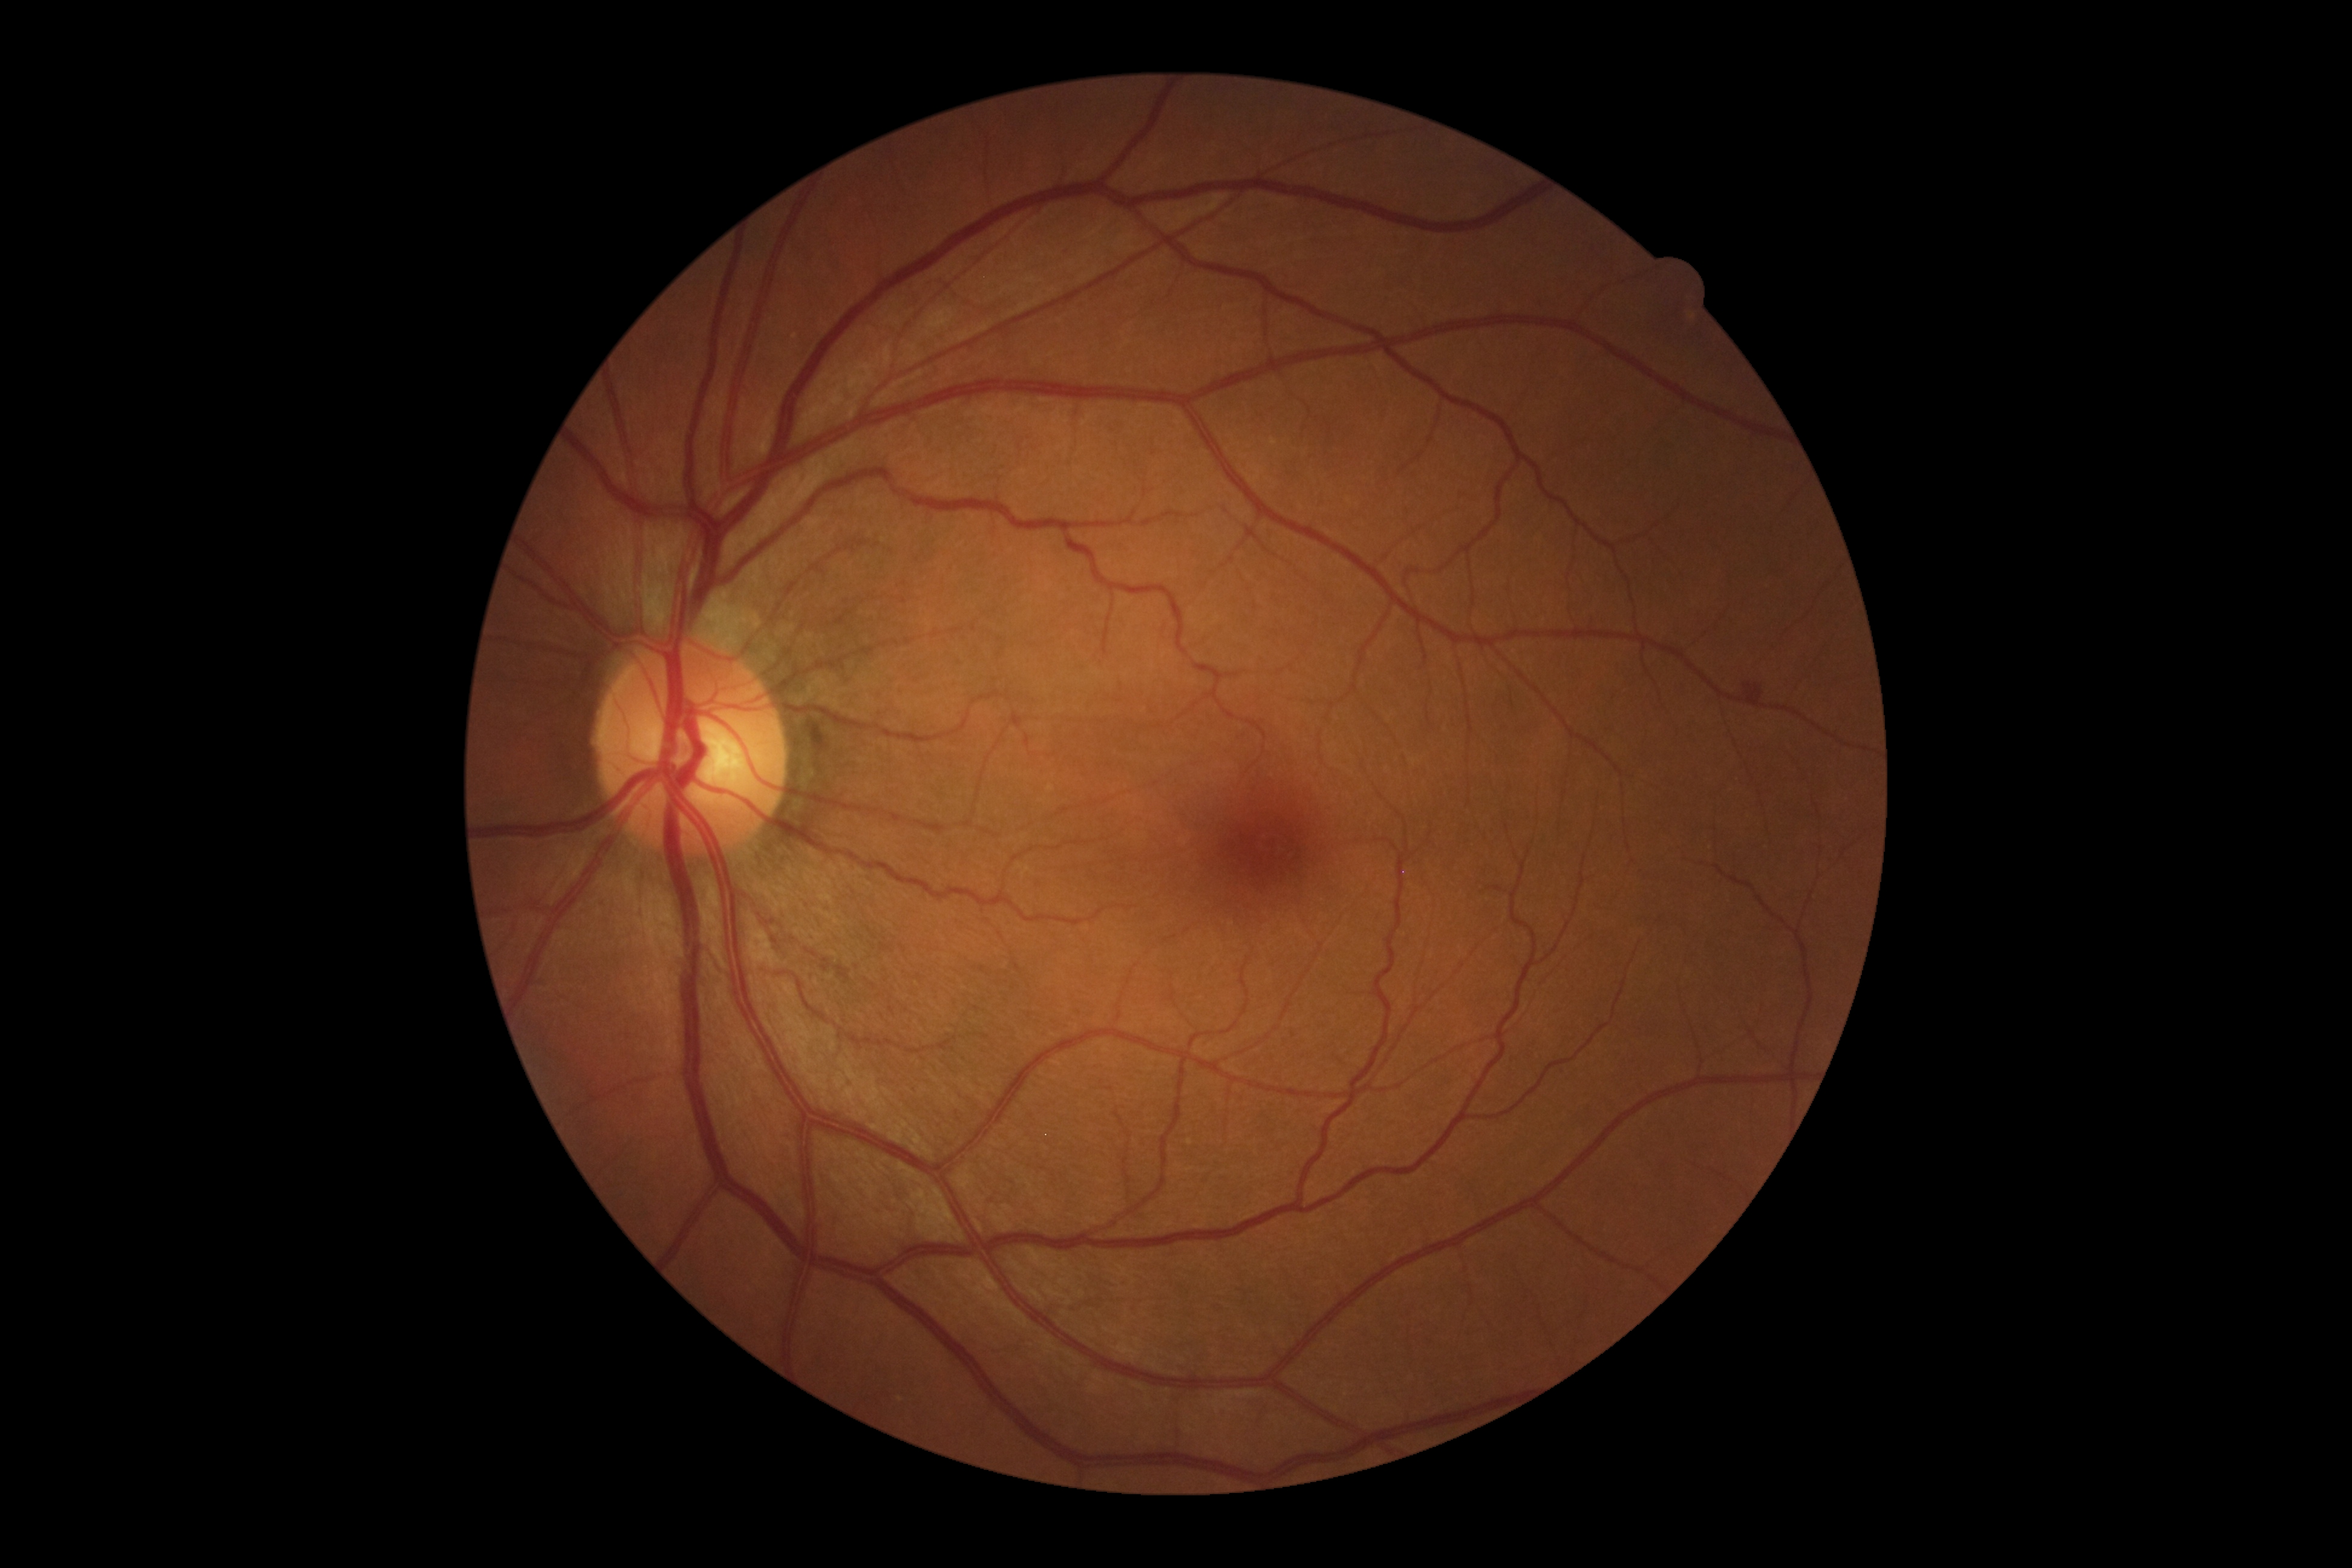 The retinopathy is classified as non-proliferative diabetic retinopathy. Diabetic retinopathy is grade 2 (moderate NPDR).